Color fundus photograph.
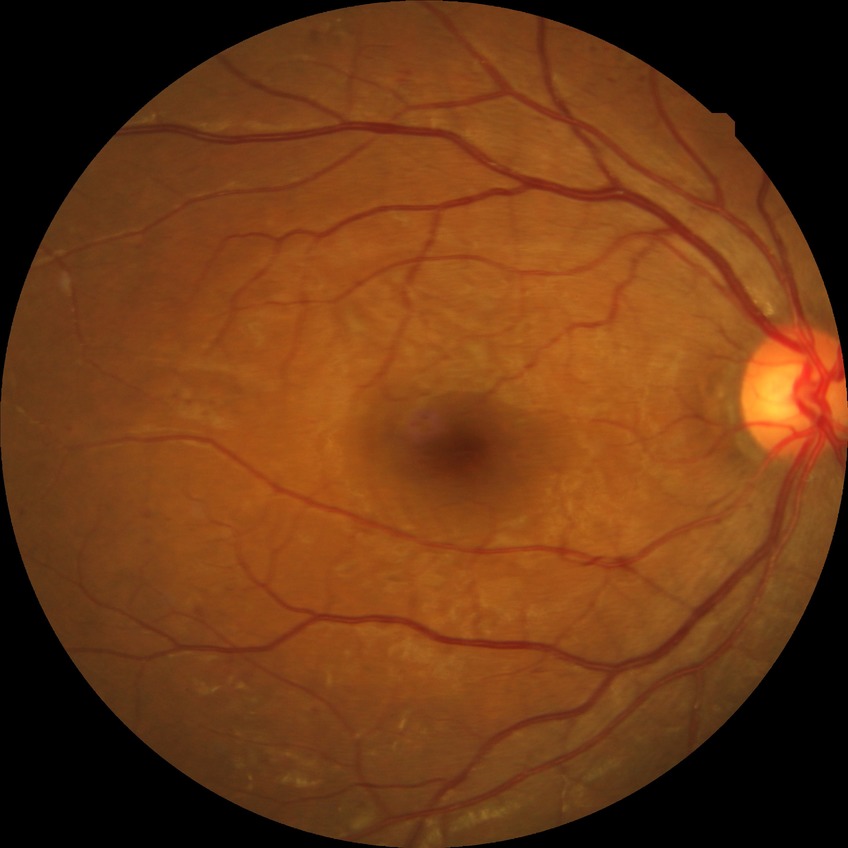 retinopathy grade@simple diabetic retinopathy, DR class@non-proliferative diabetic retinopathy.